No pharmacologic dilation.
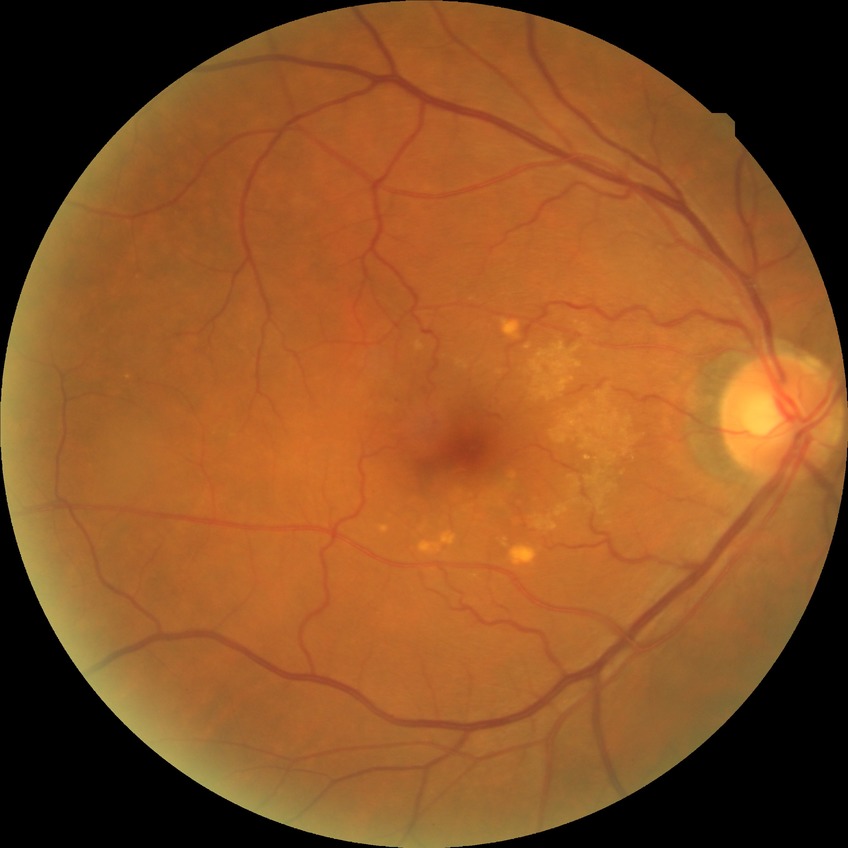

Modified Davis grading: simple diabetic retinopathy.